Modified Davis classification. FOV: 45 degrees. 848 x 848 pixels.
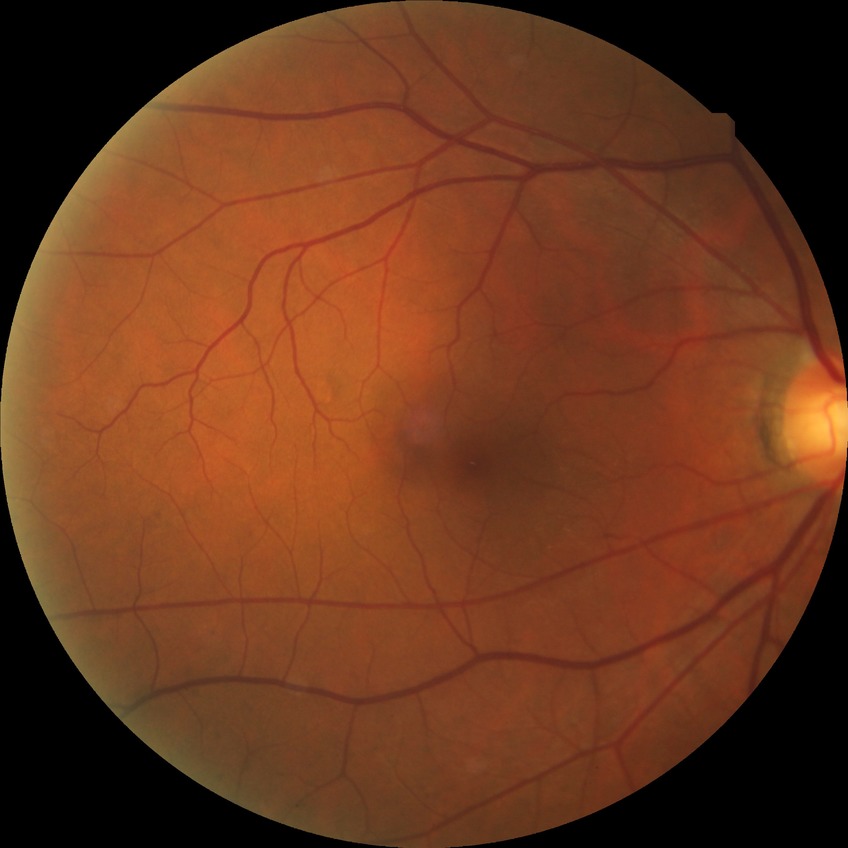

Davis grading: no diabetic retinopathy.